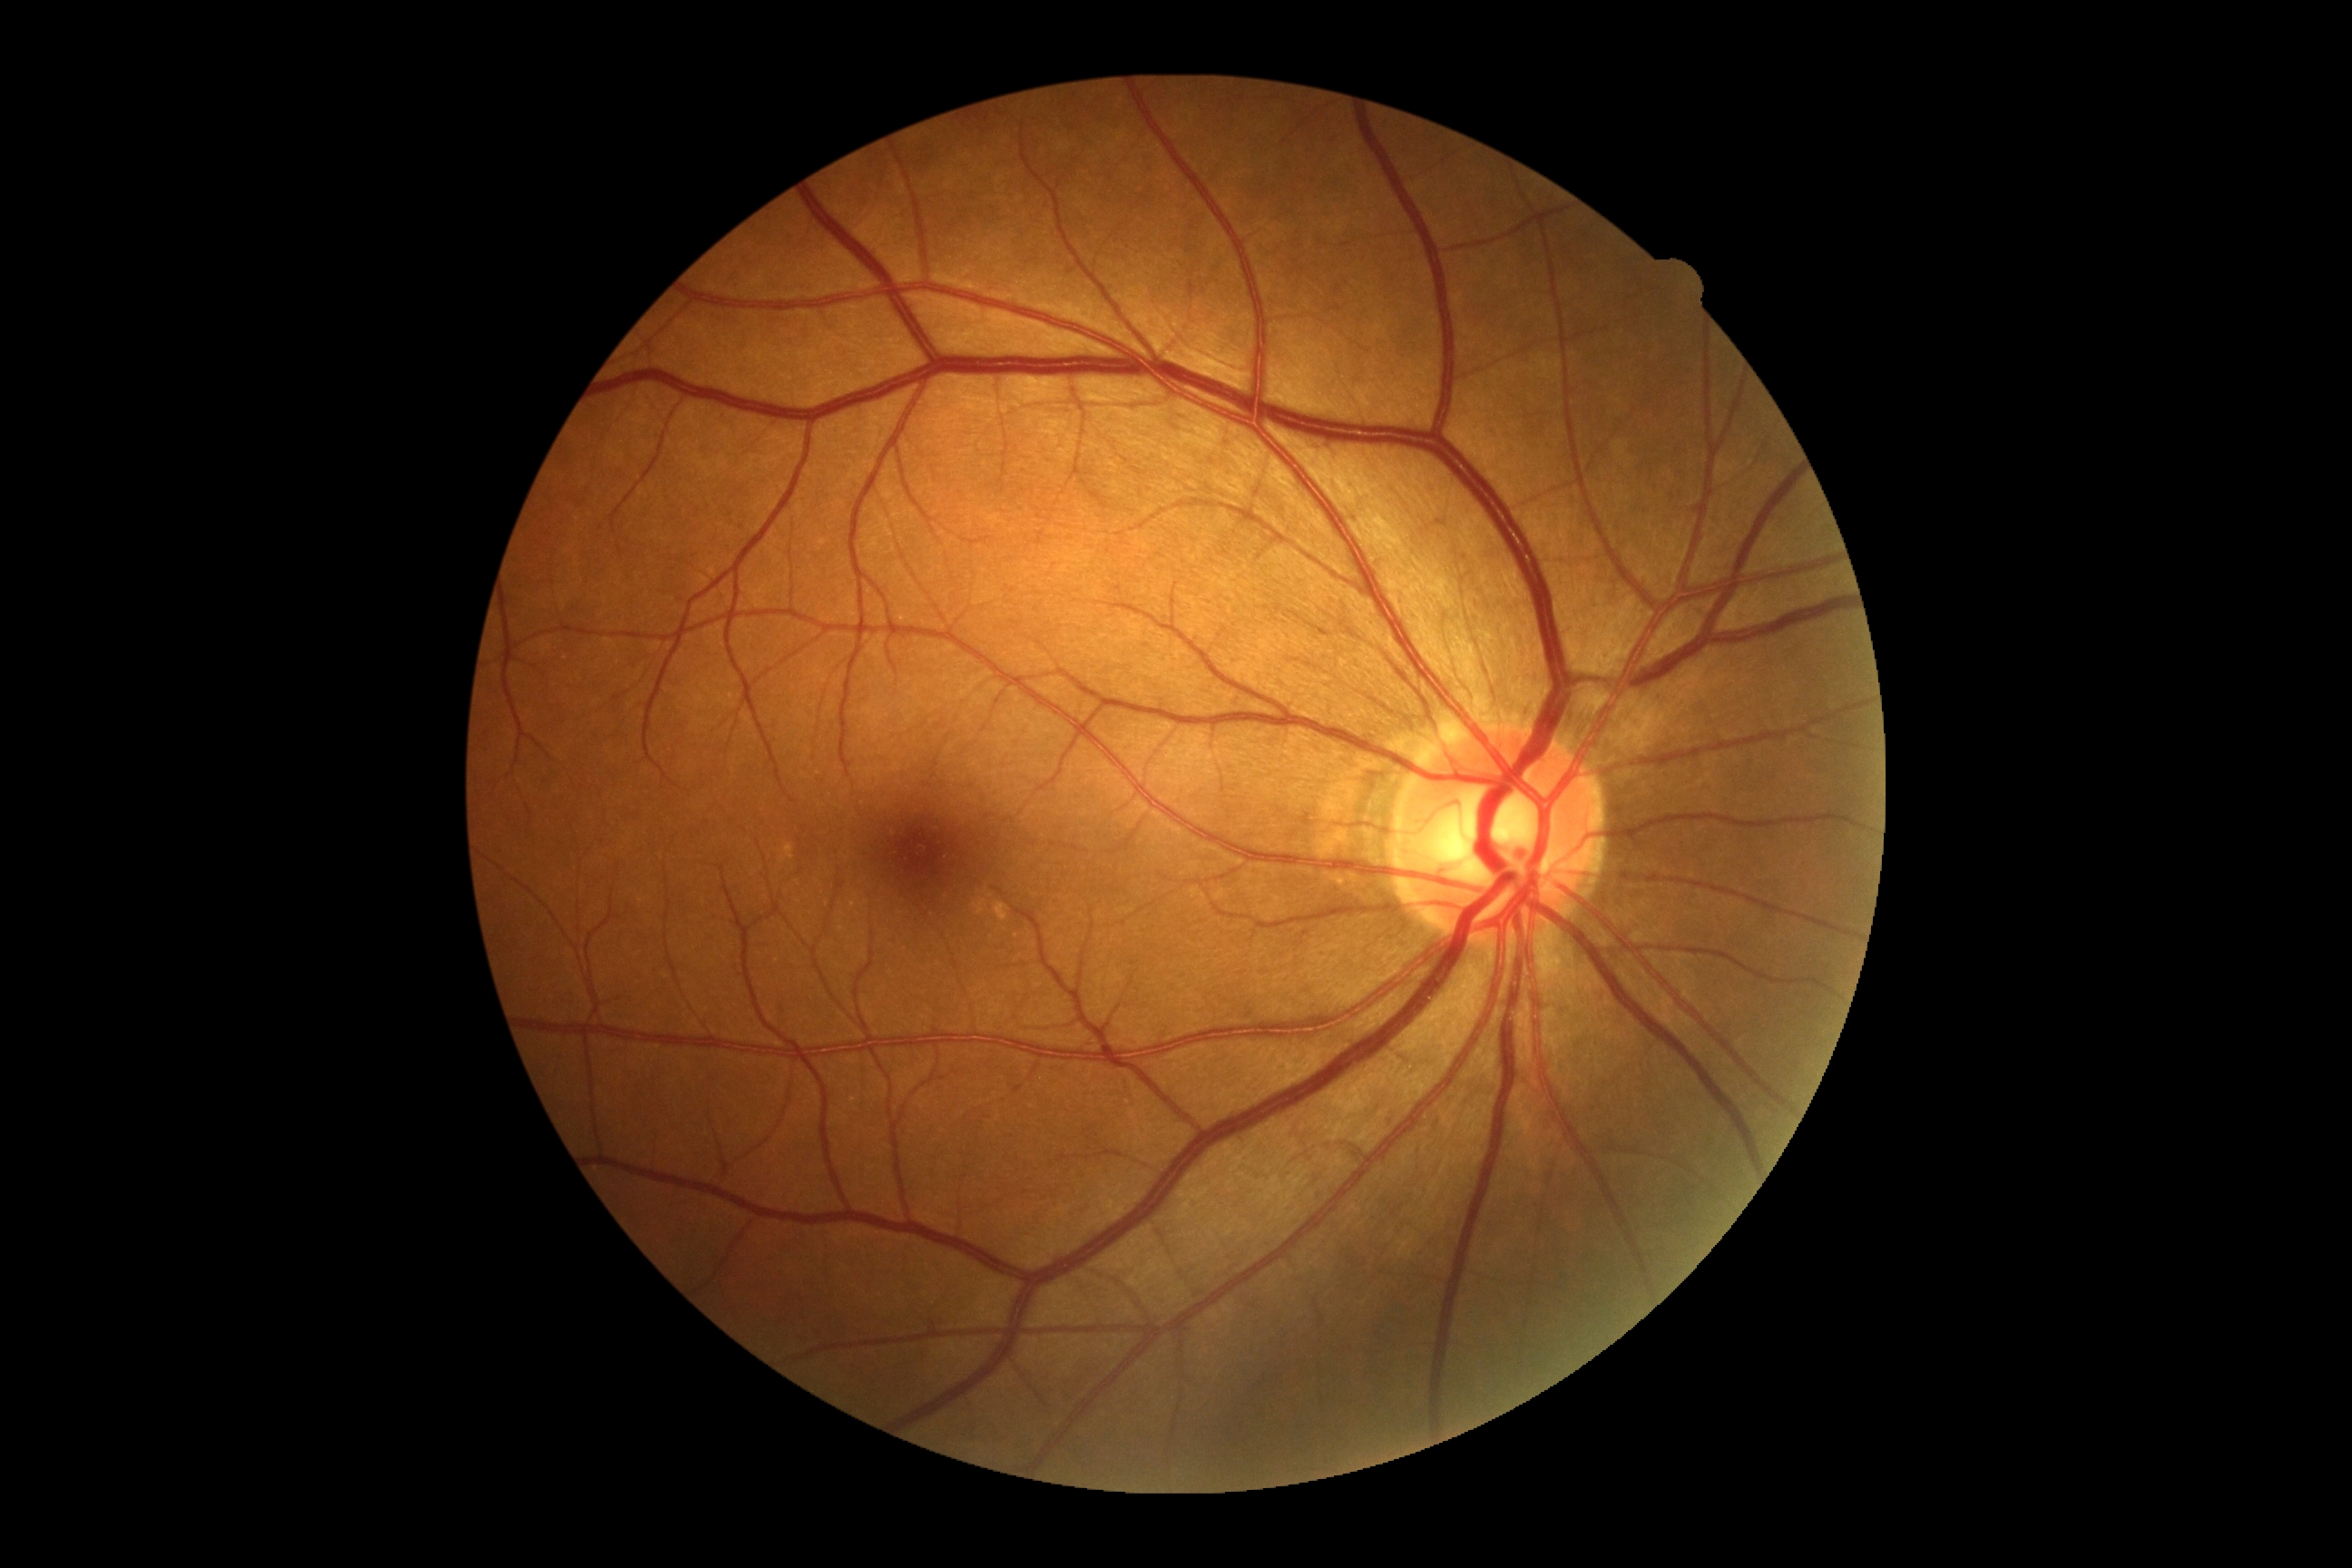

DR severity: grade 0.